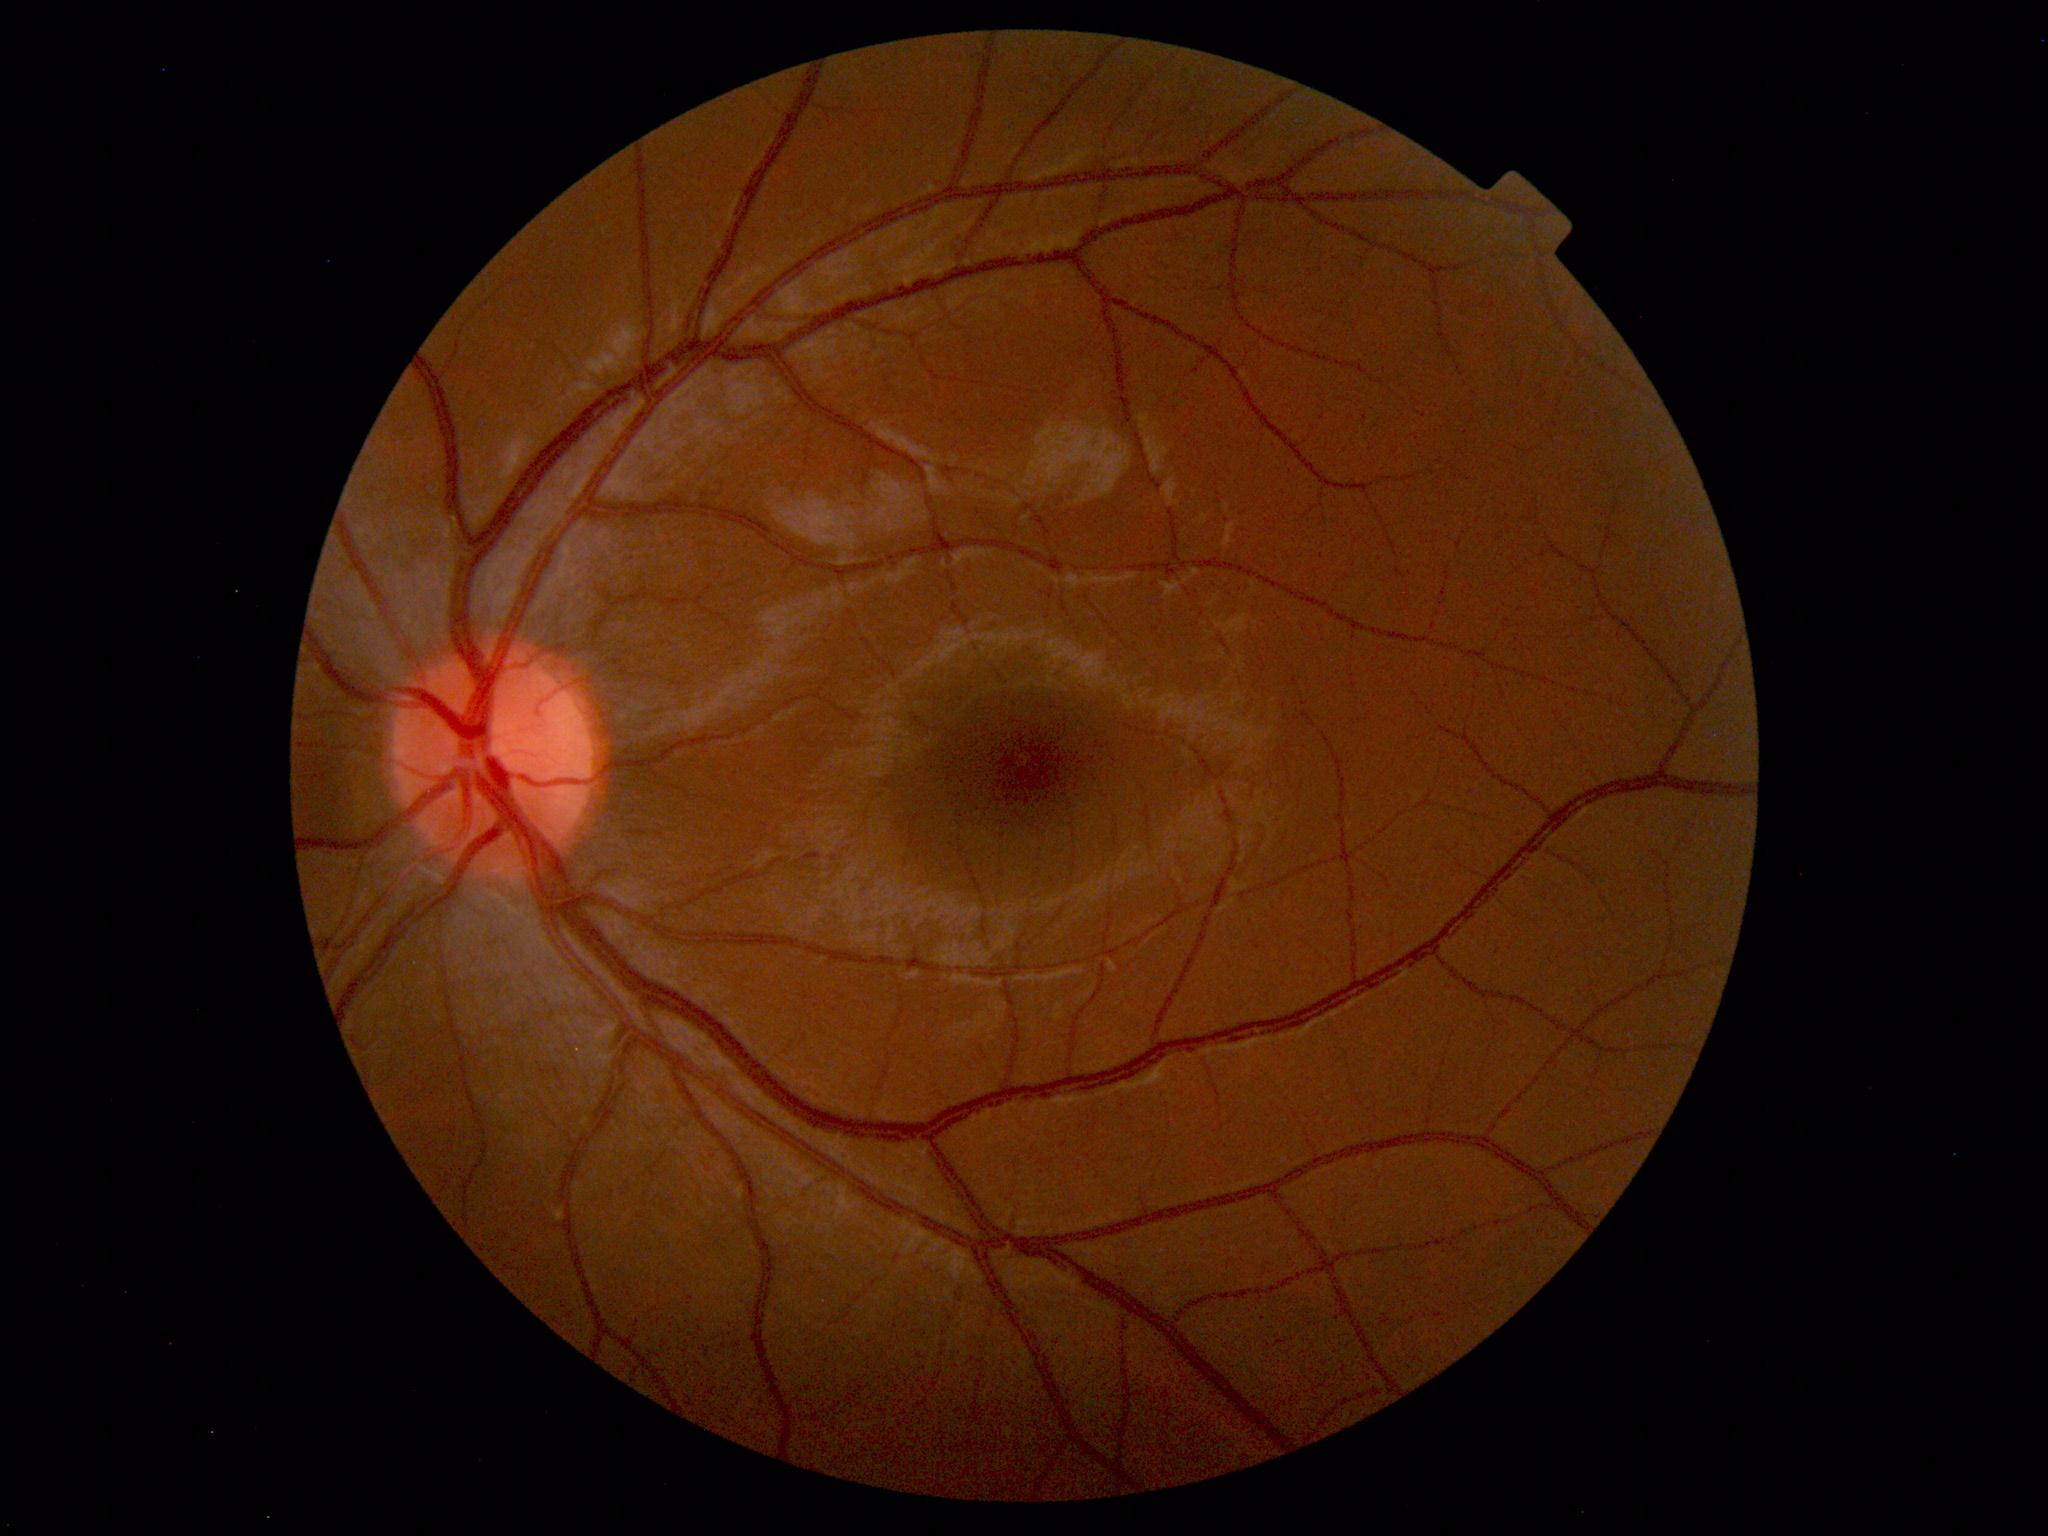 Findings: no abnormalities.